Camera: NIDEK AFC-230.
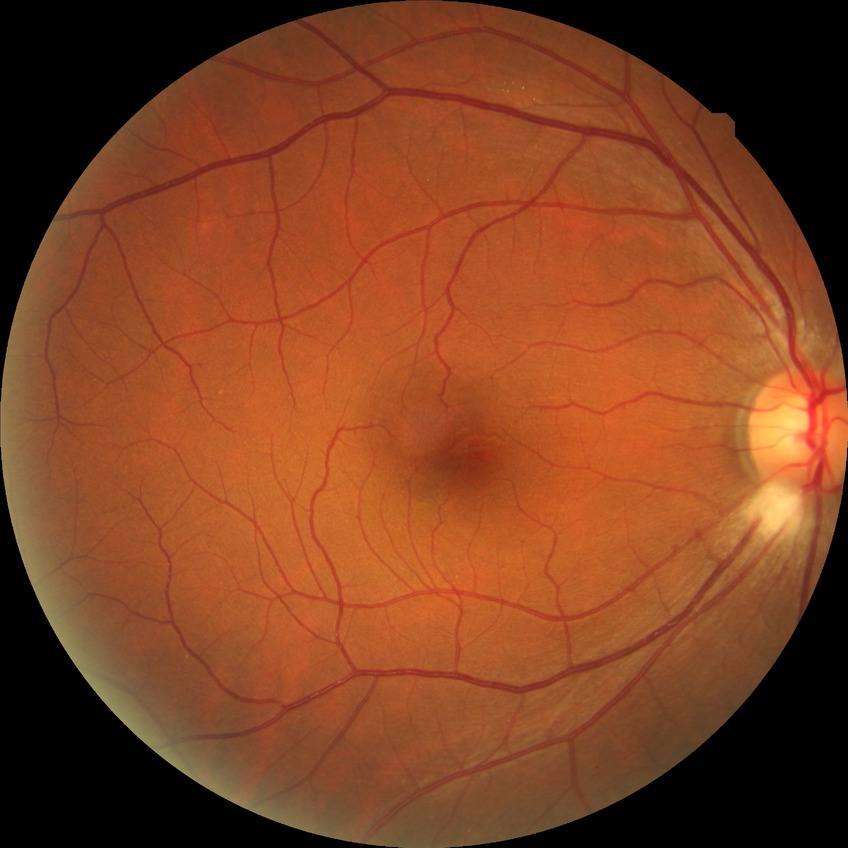

davis_grade: no diabetic retinopathy (NDR)